Camera: Clarity RetCam 3 (130° FOV). Infant wide-field retinal image.
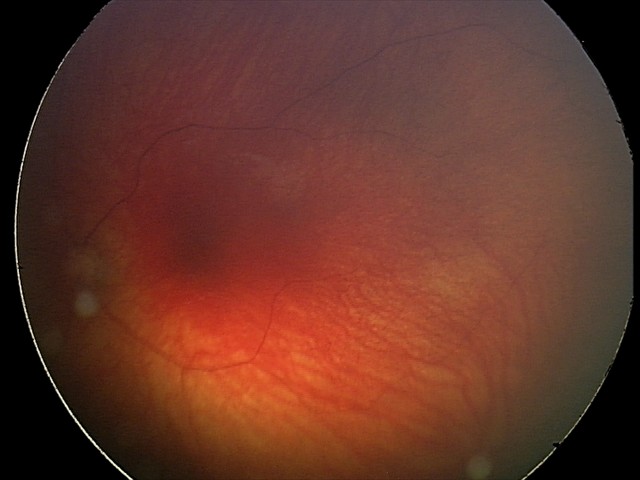 Impression: optic nerve hypoplasia.